Wide-field fundus image from infant ROP screening · captured with the Natus RetCam Envision (130° field of view):
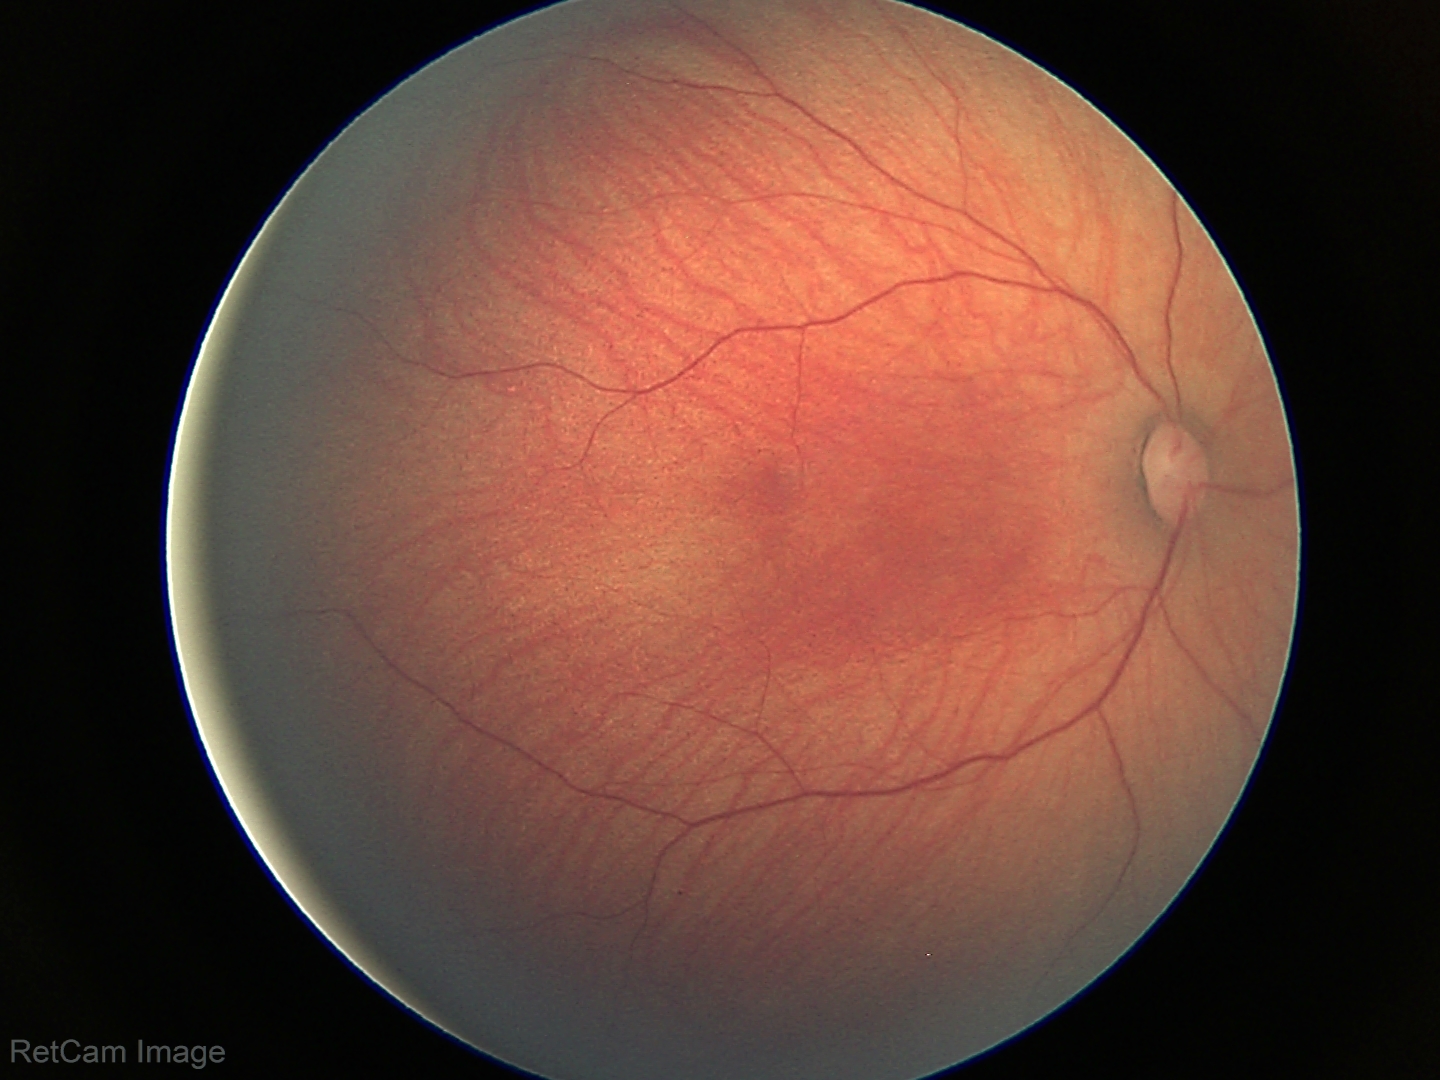

Normal screening examination.